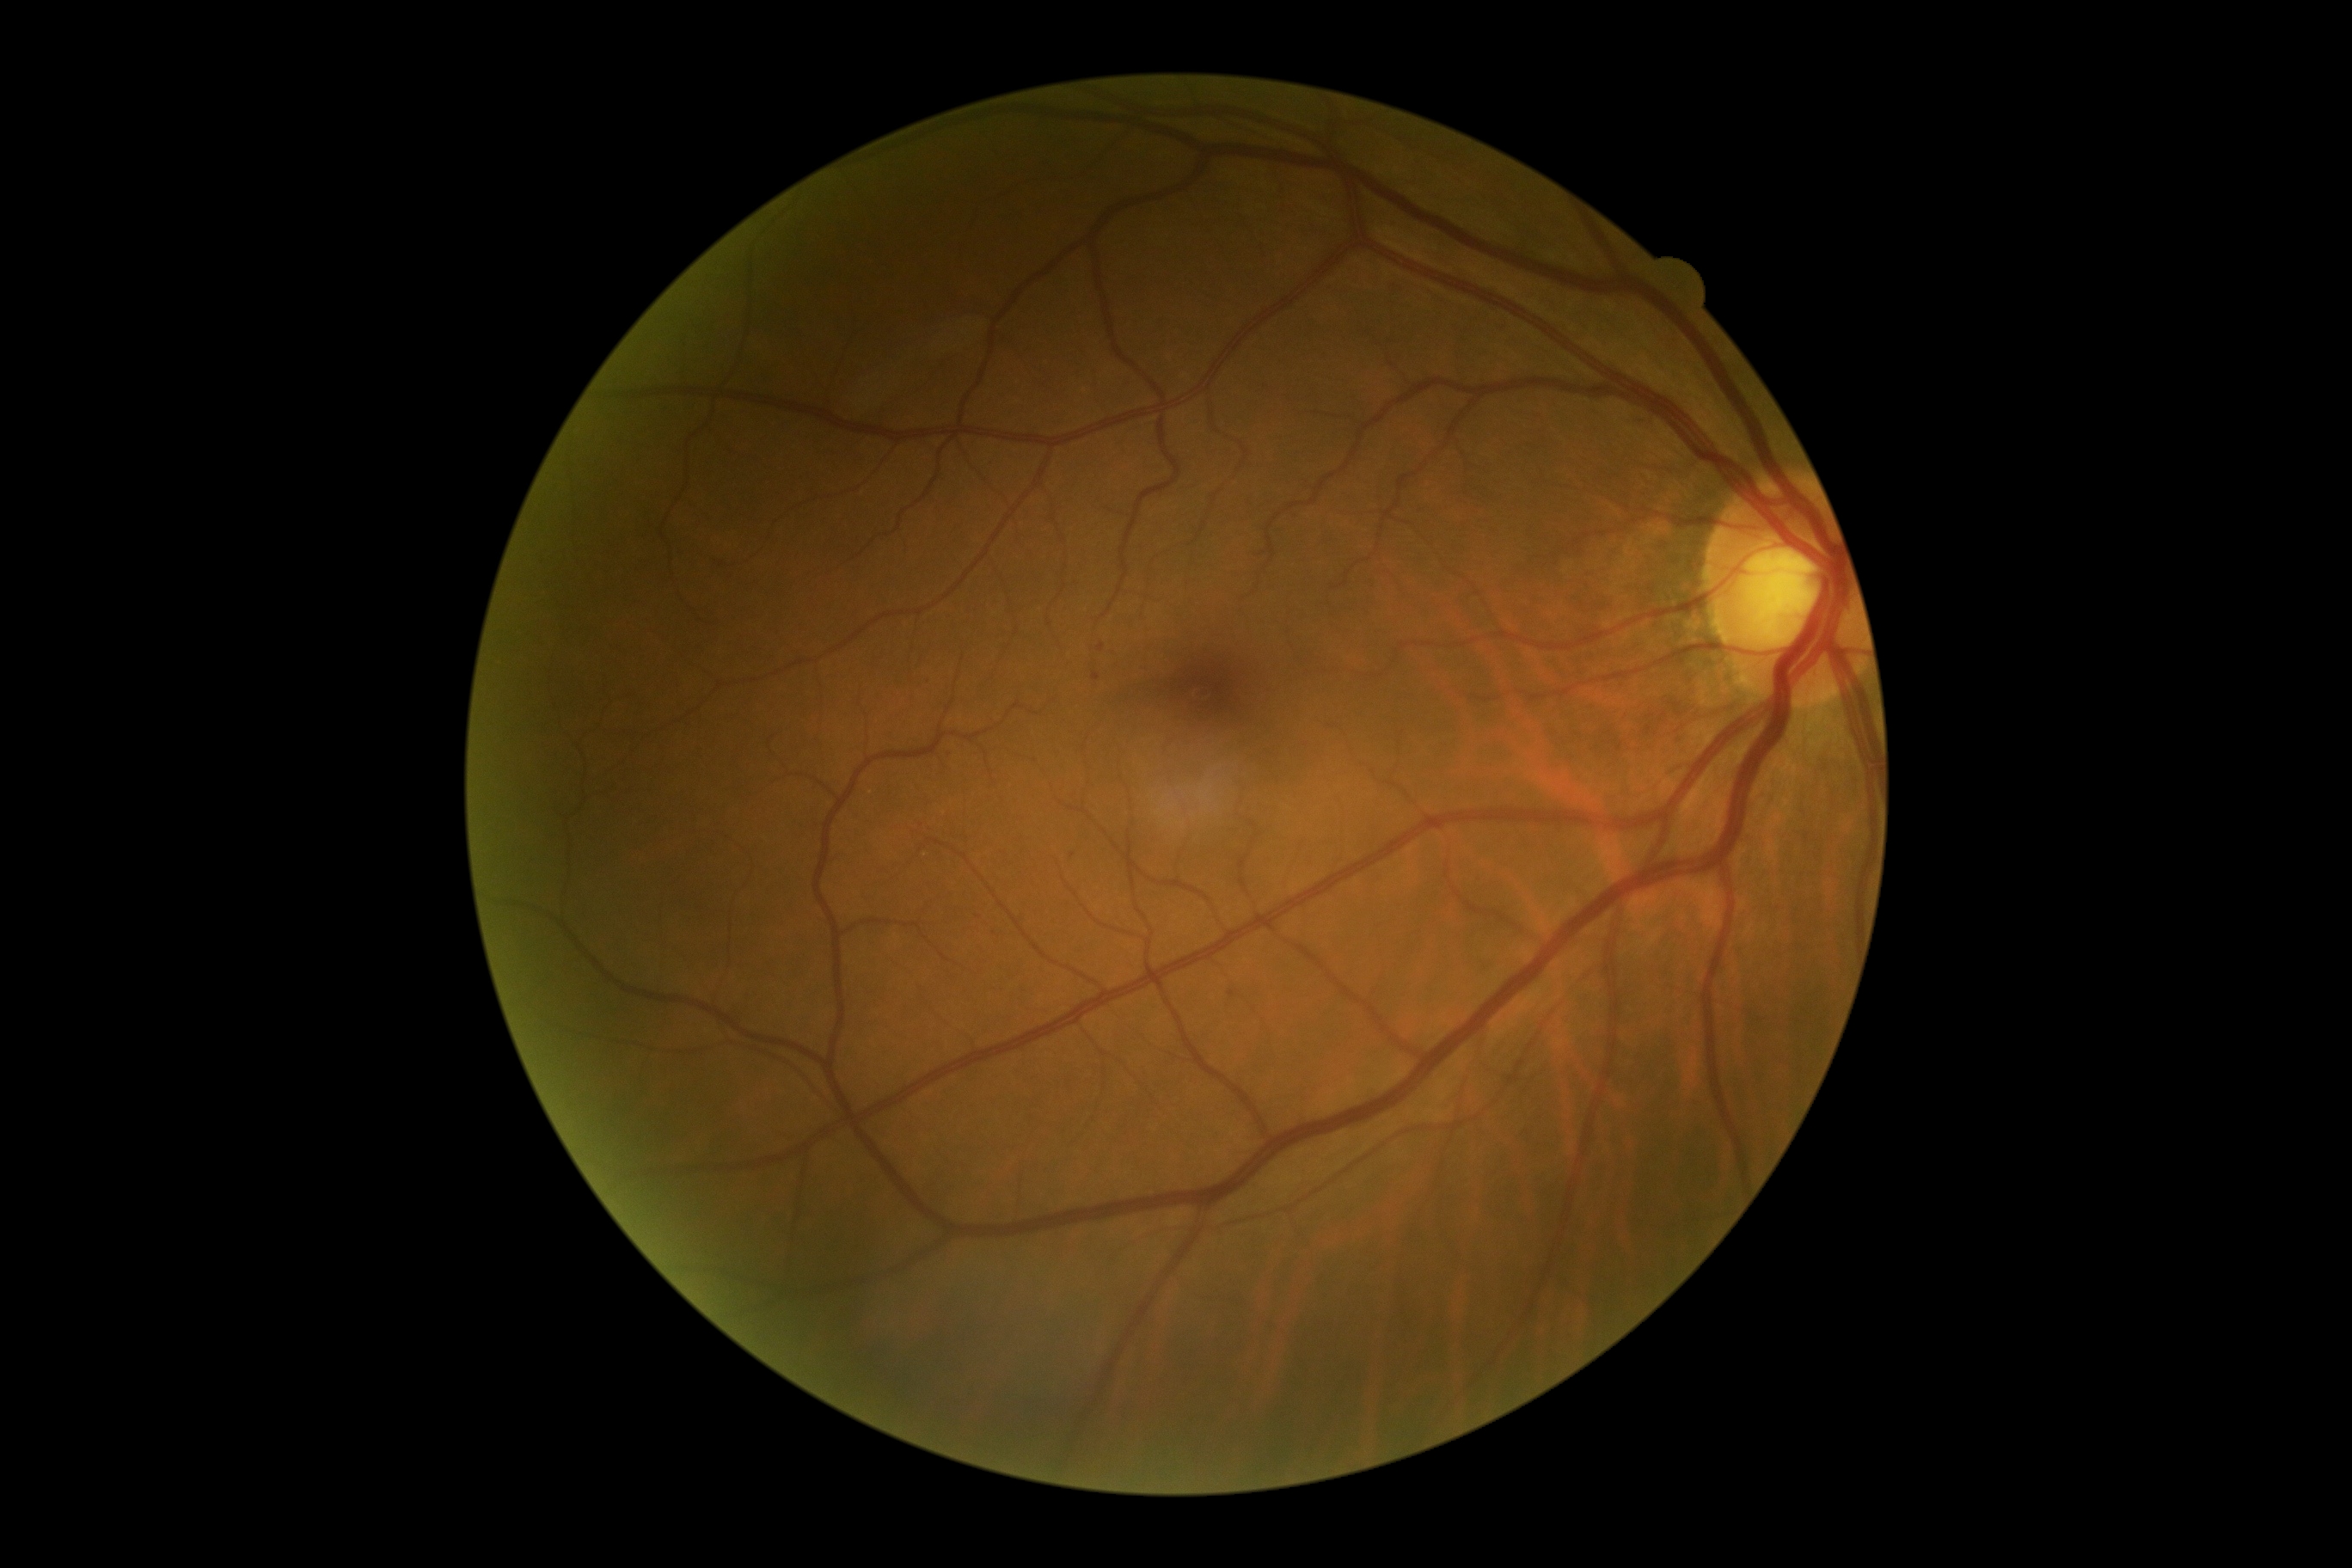
Annotations:
* diabetic retinopathy grade — 1 — presence of microaneurysms only